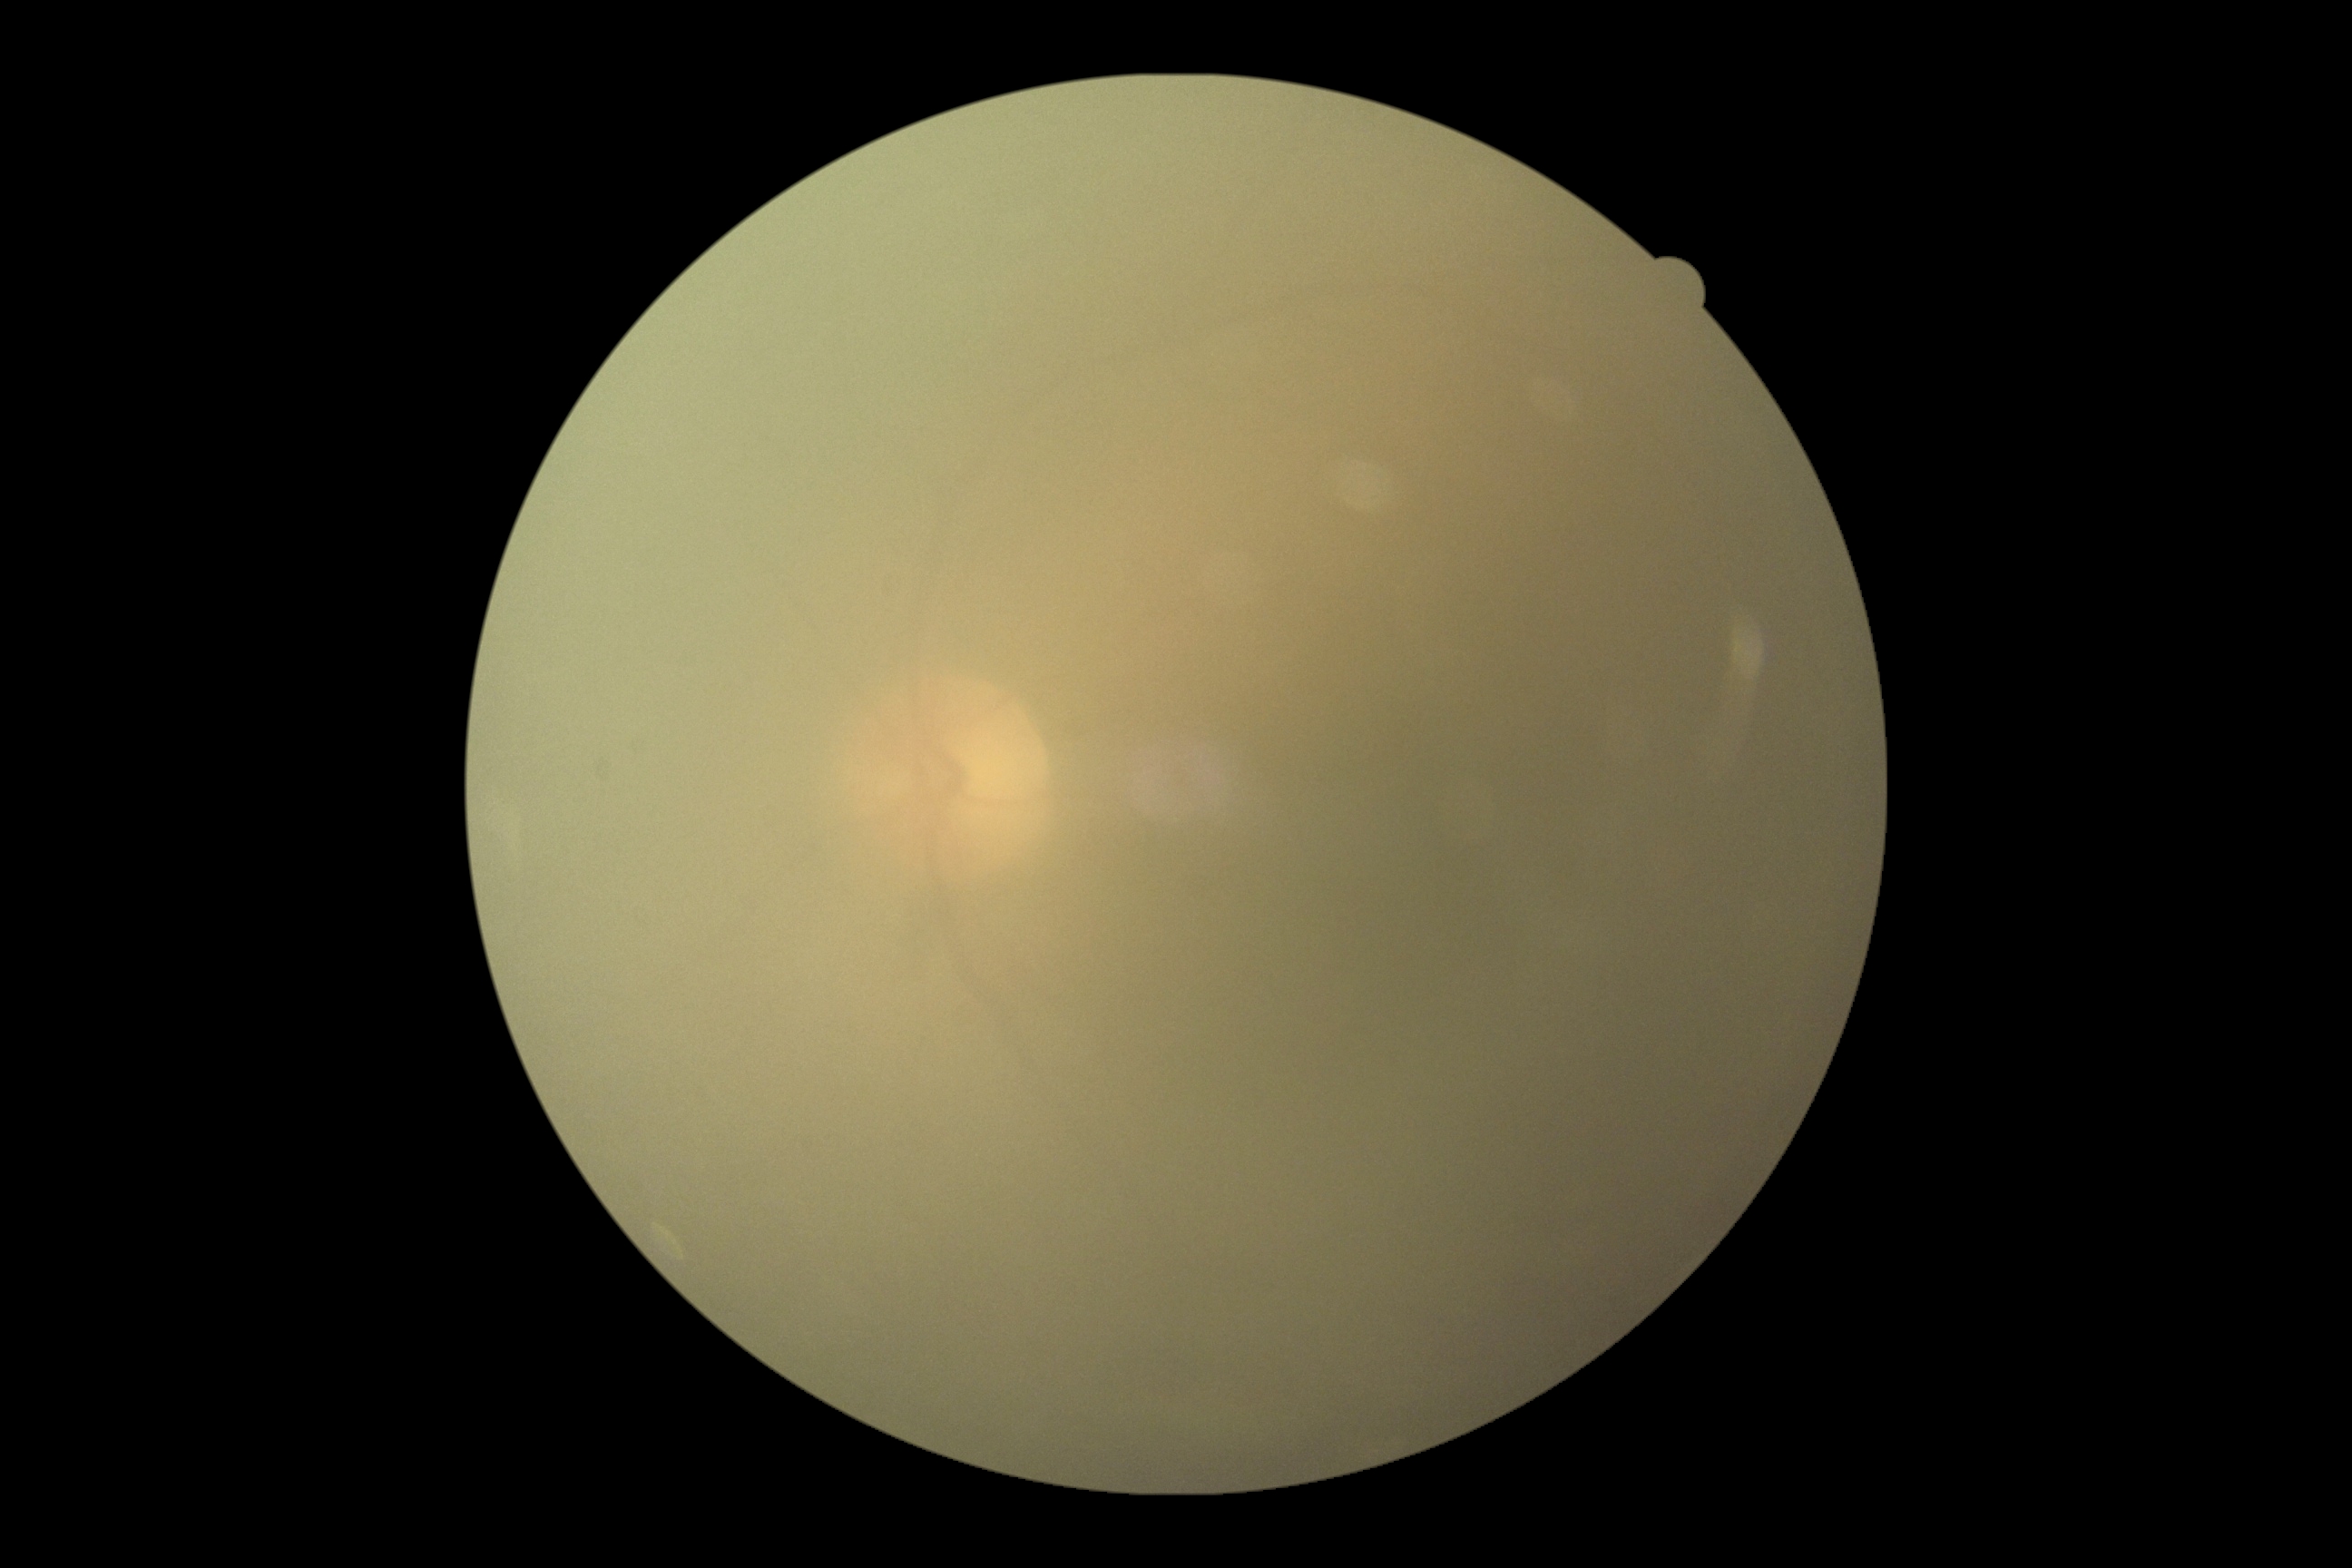 Retinopathy is ungradable. The image cannot be graded for diabetic retinopathy.